Image size 2352x1568:
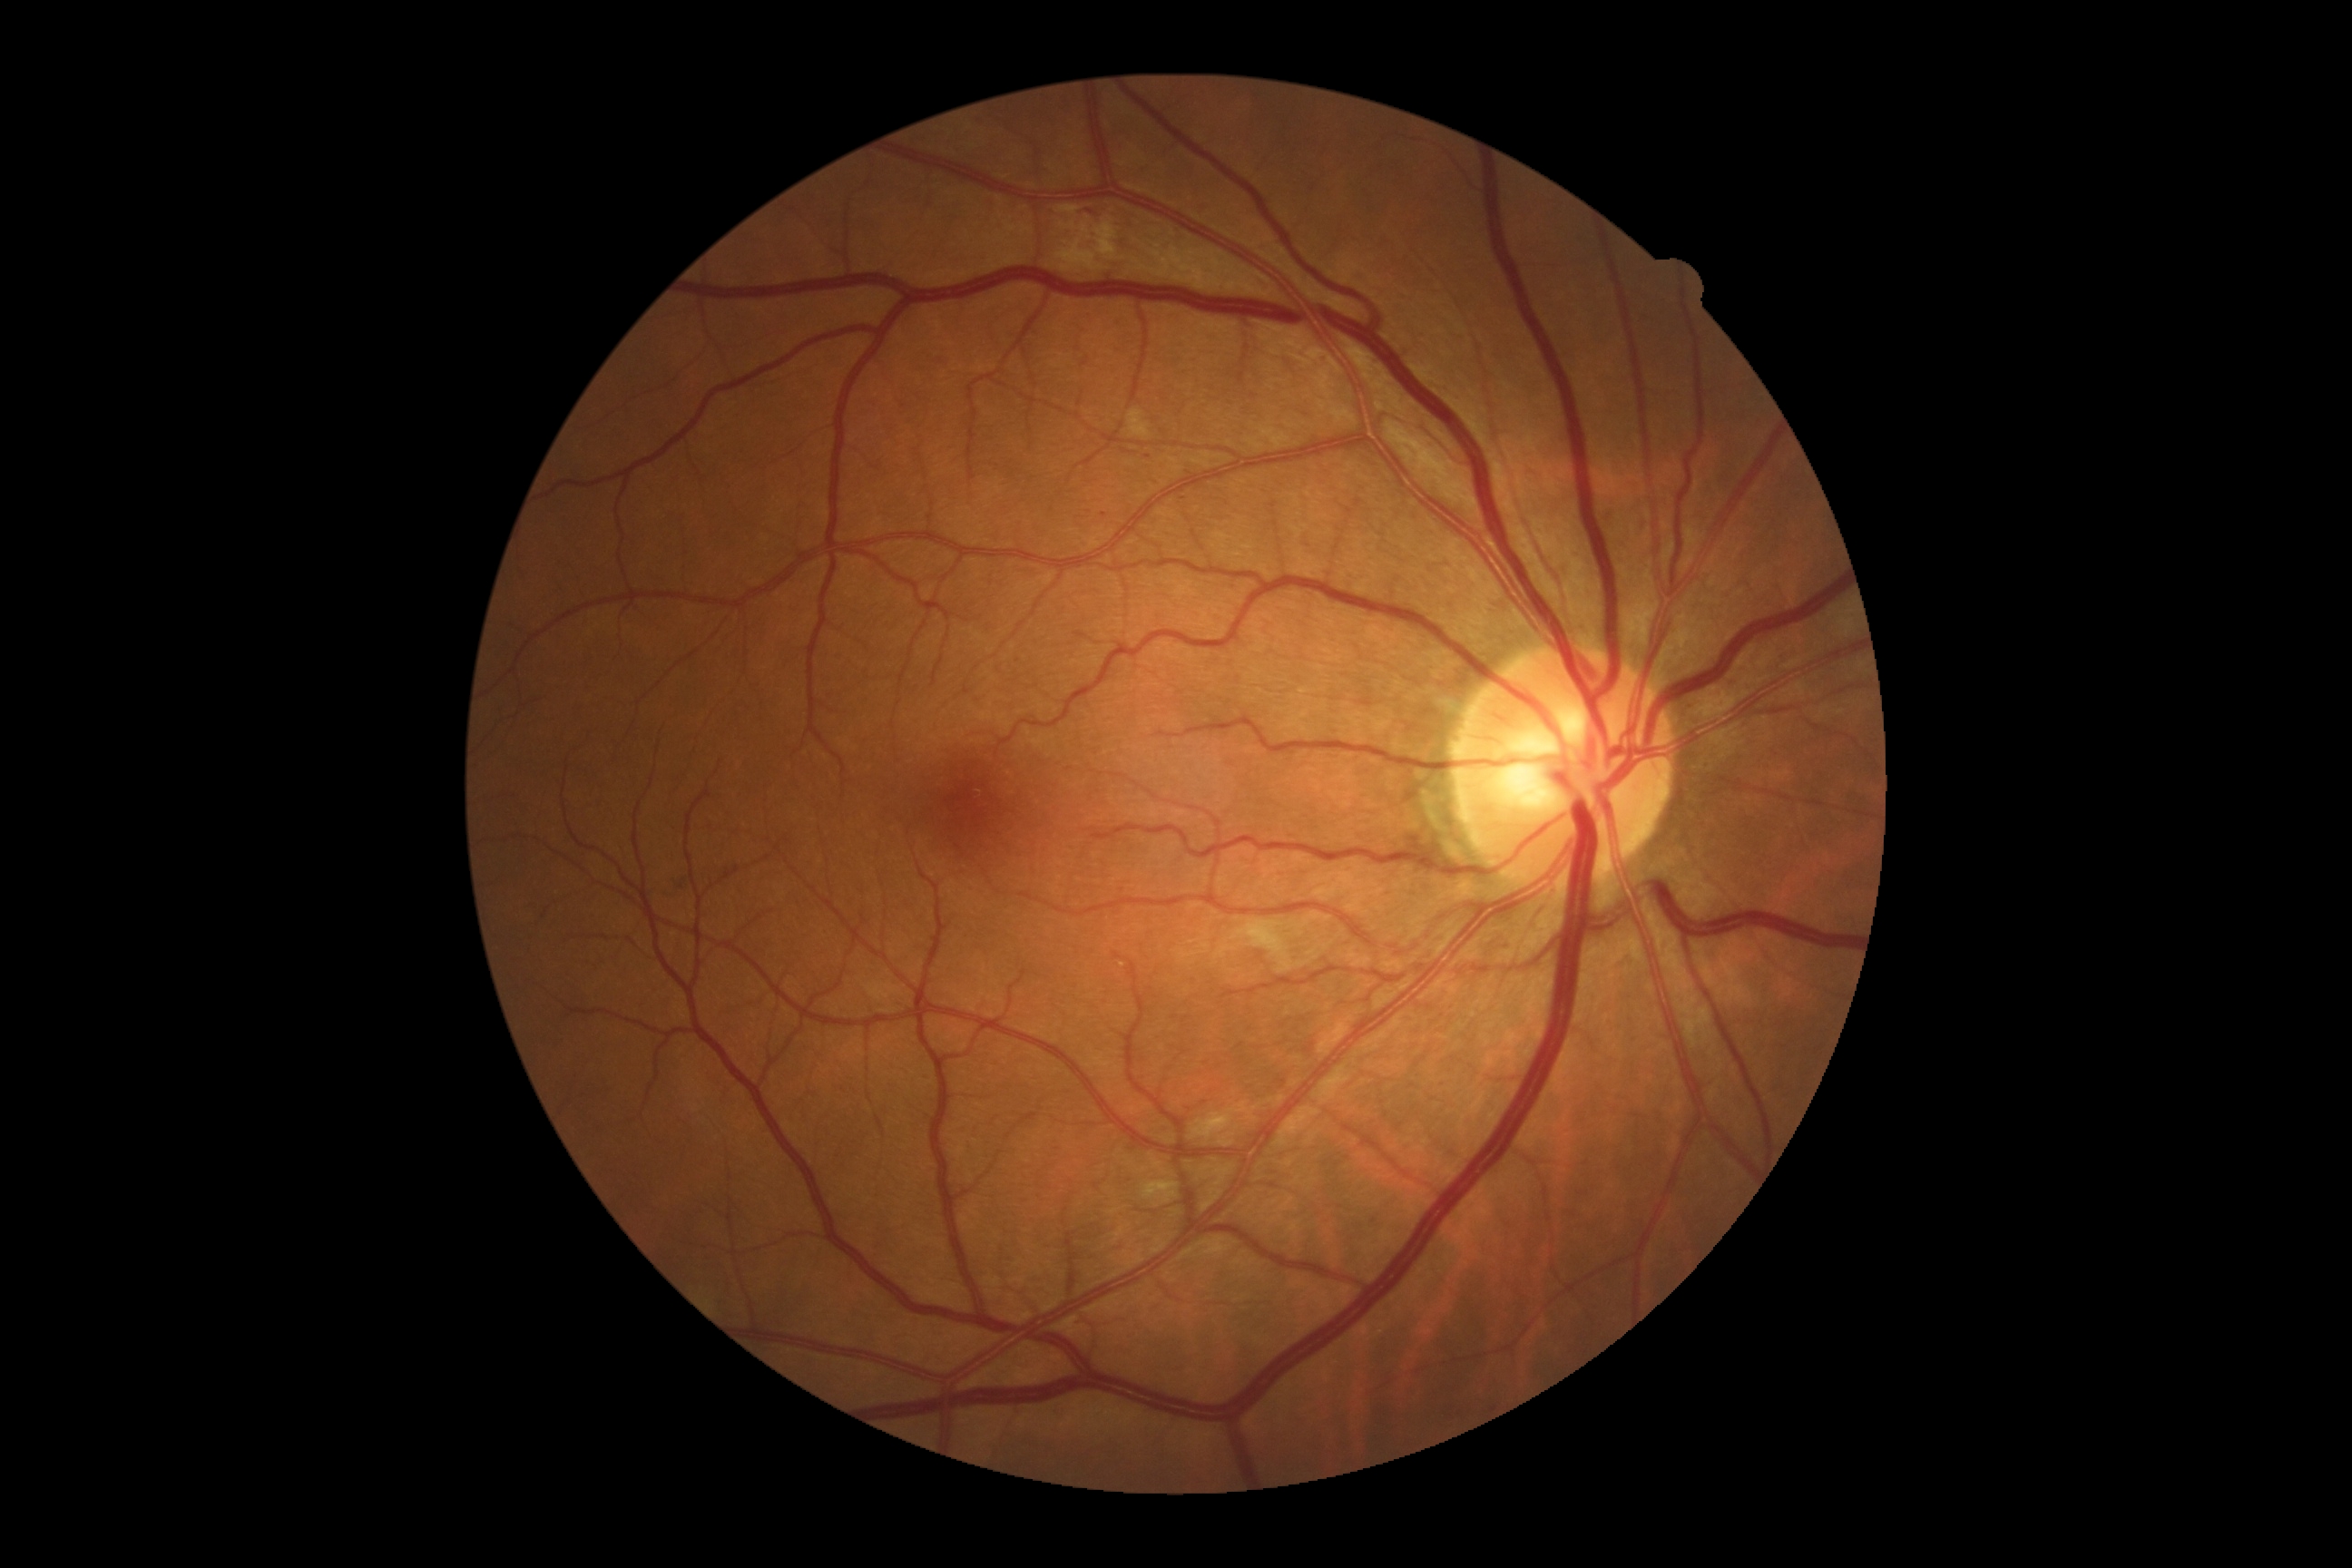

• diabetic retinopathy (DR): grade 2 (moderate NPDR)